Image size 2352x1568; fundus photo
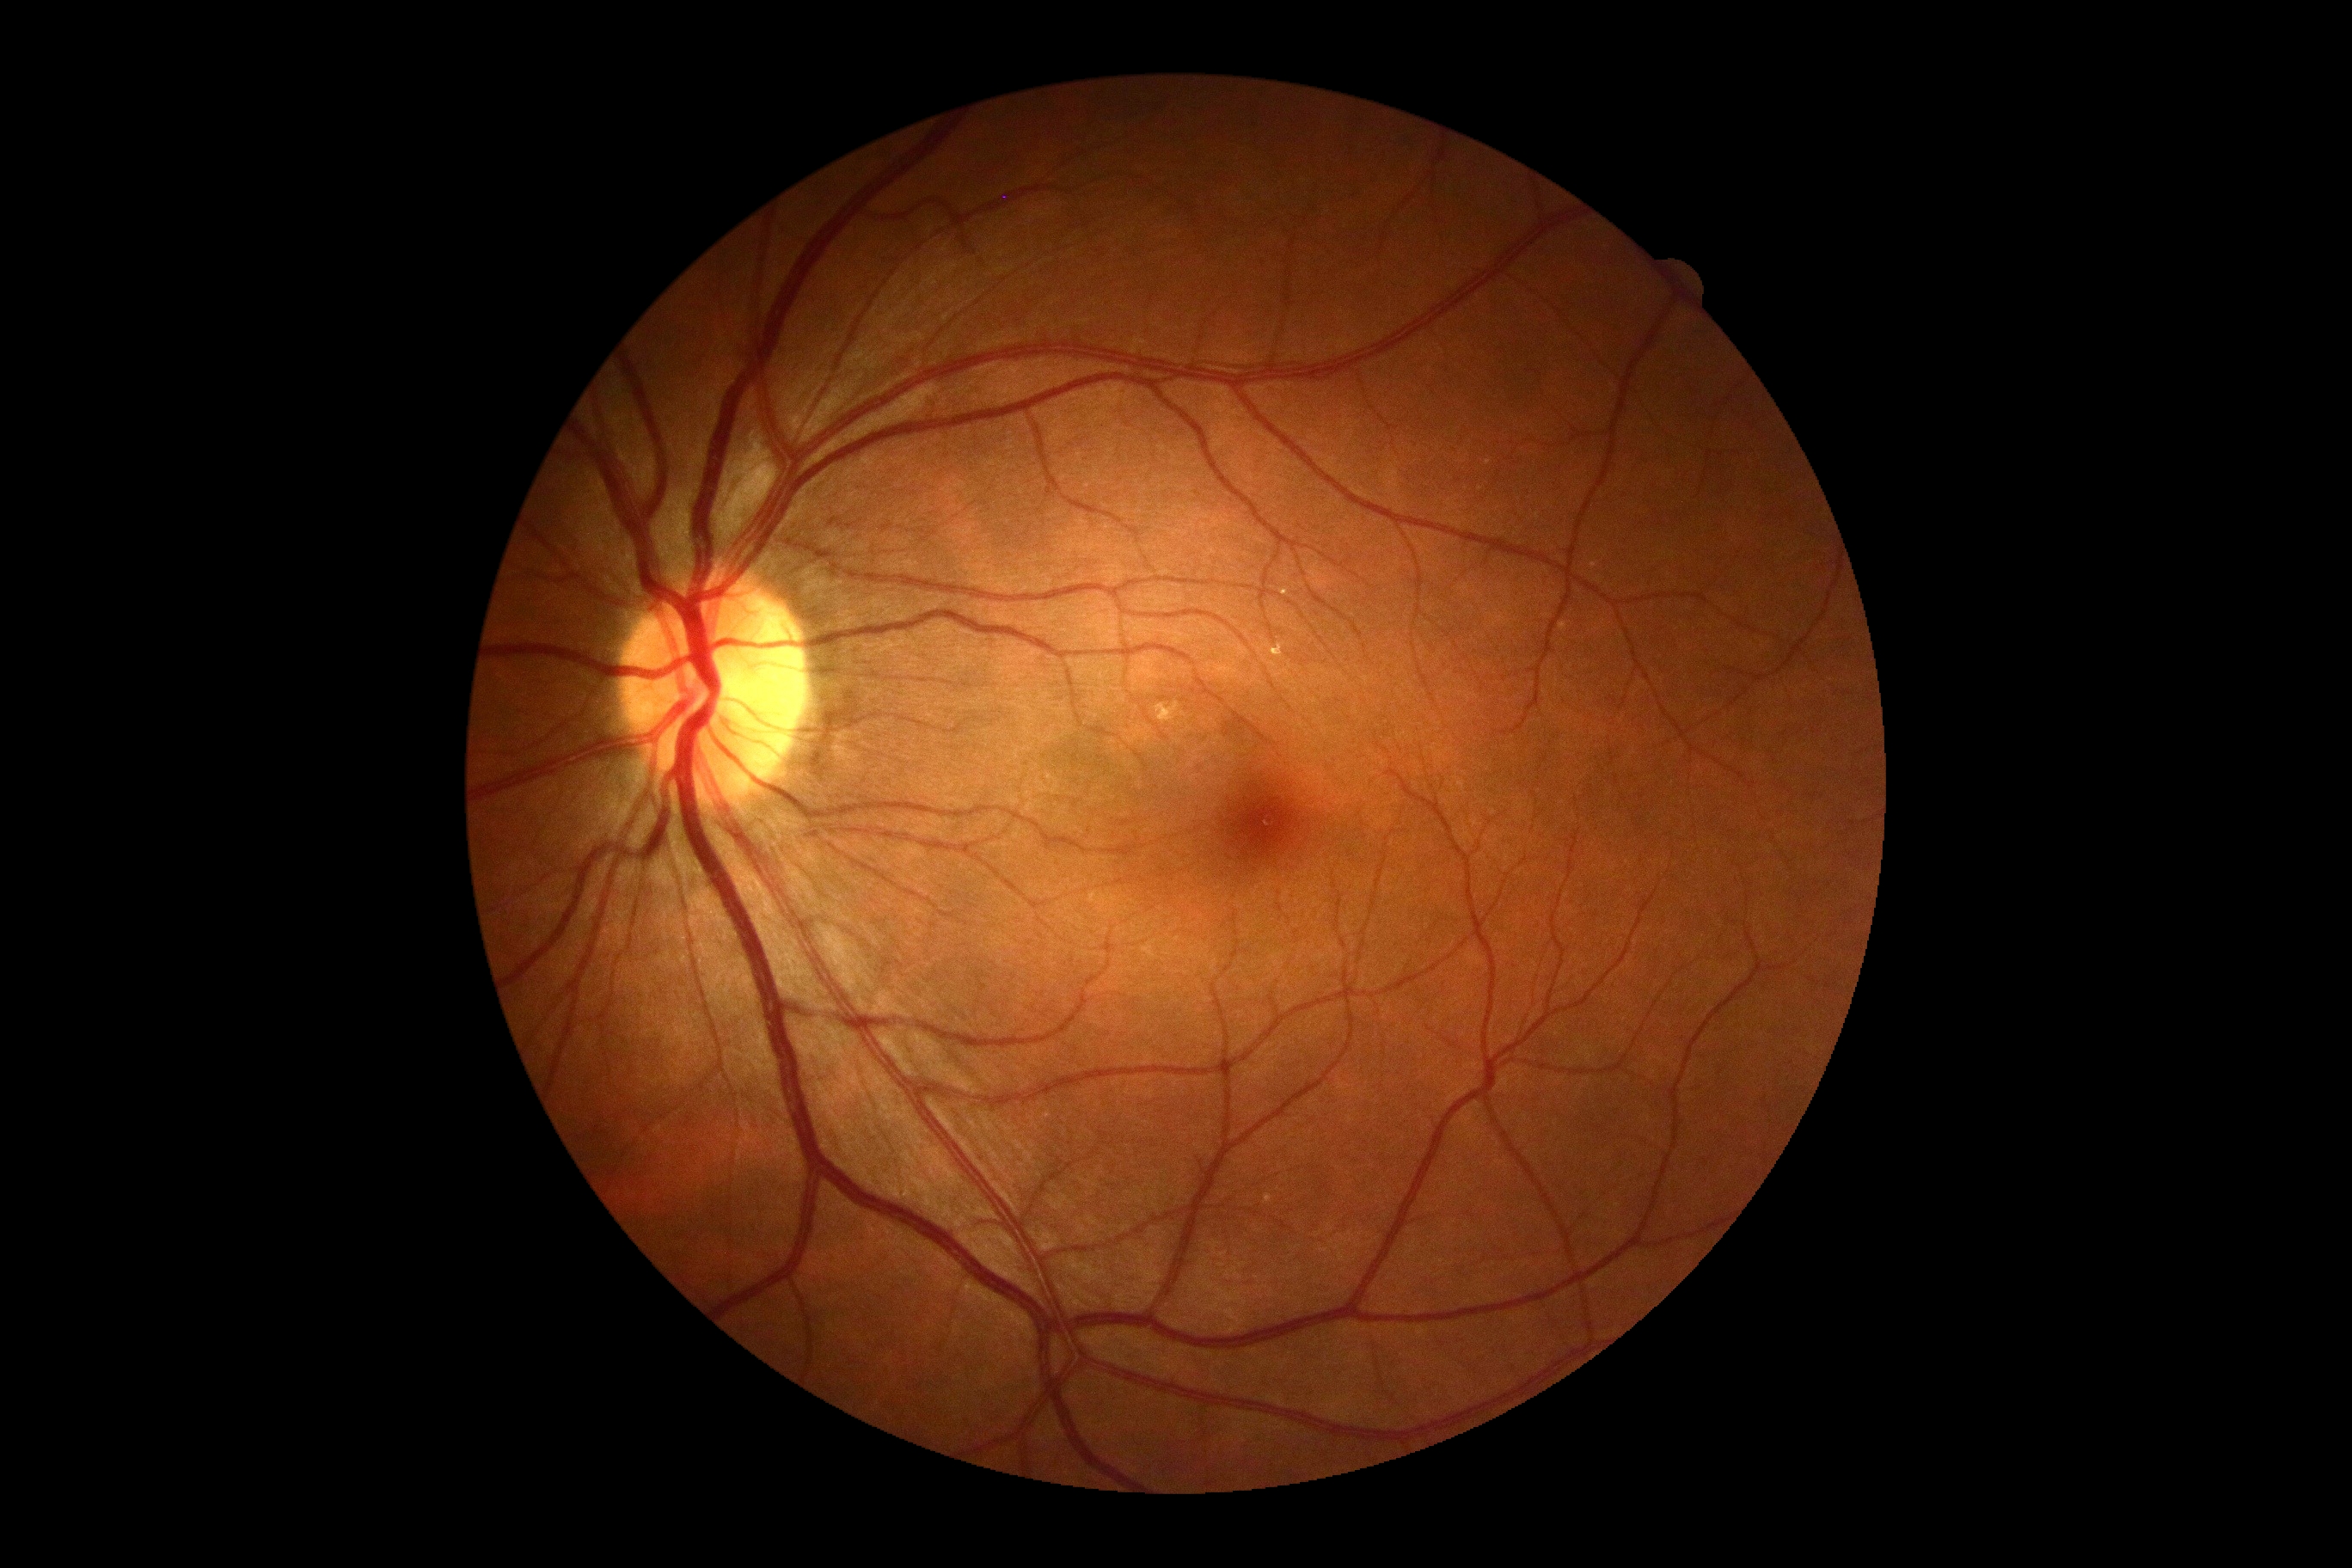

Diabetic retinopathy severity: 0/4.